68-year-old patient. Axial length: 23.6 mm: 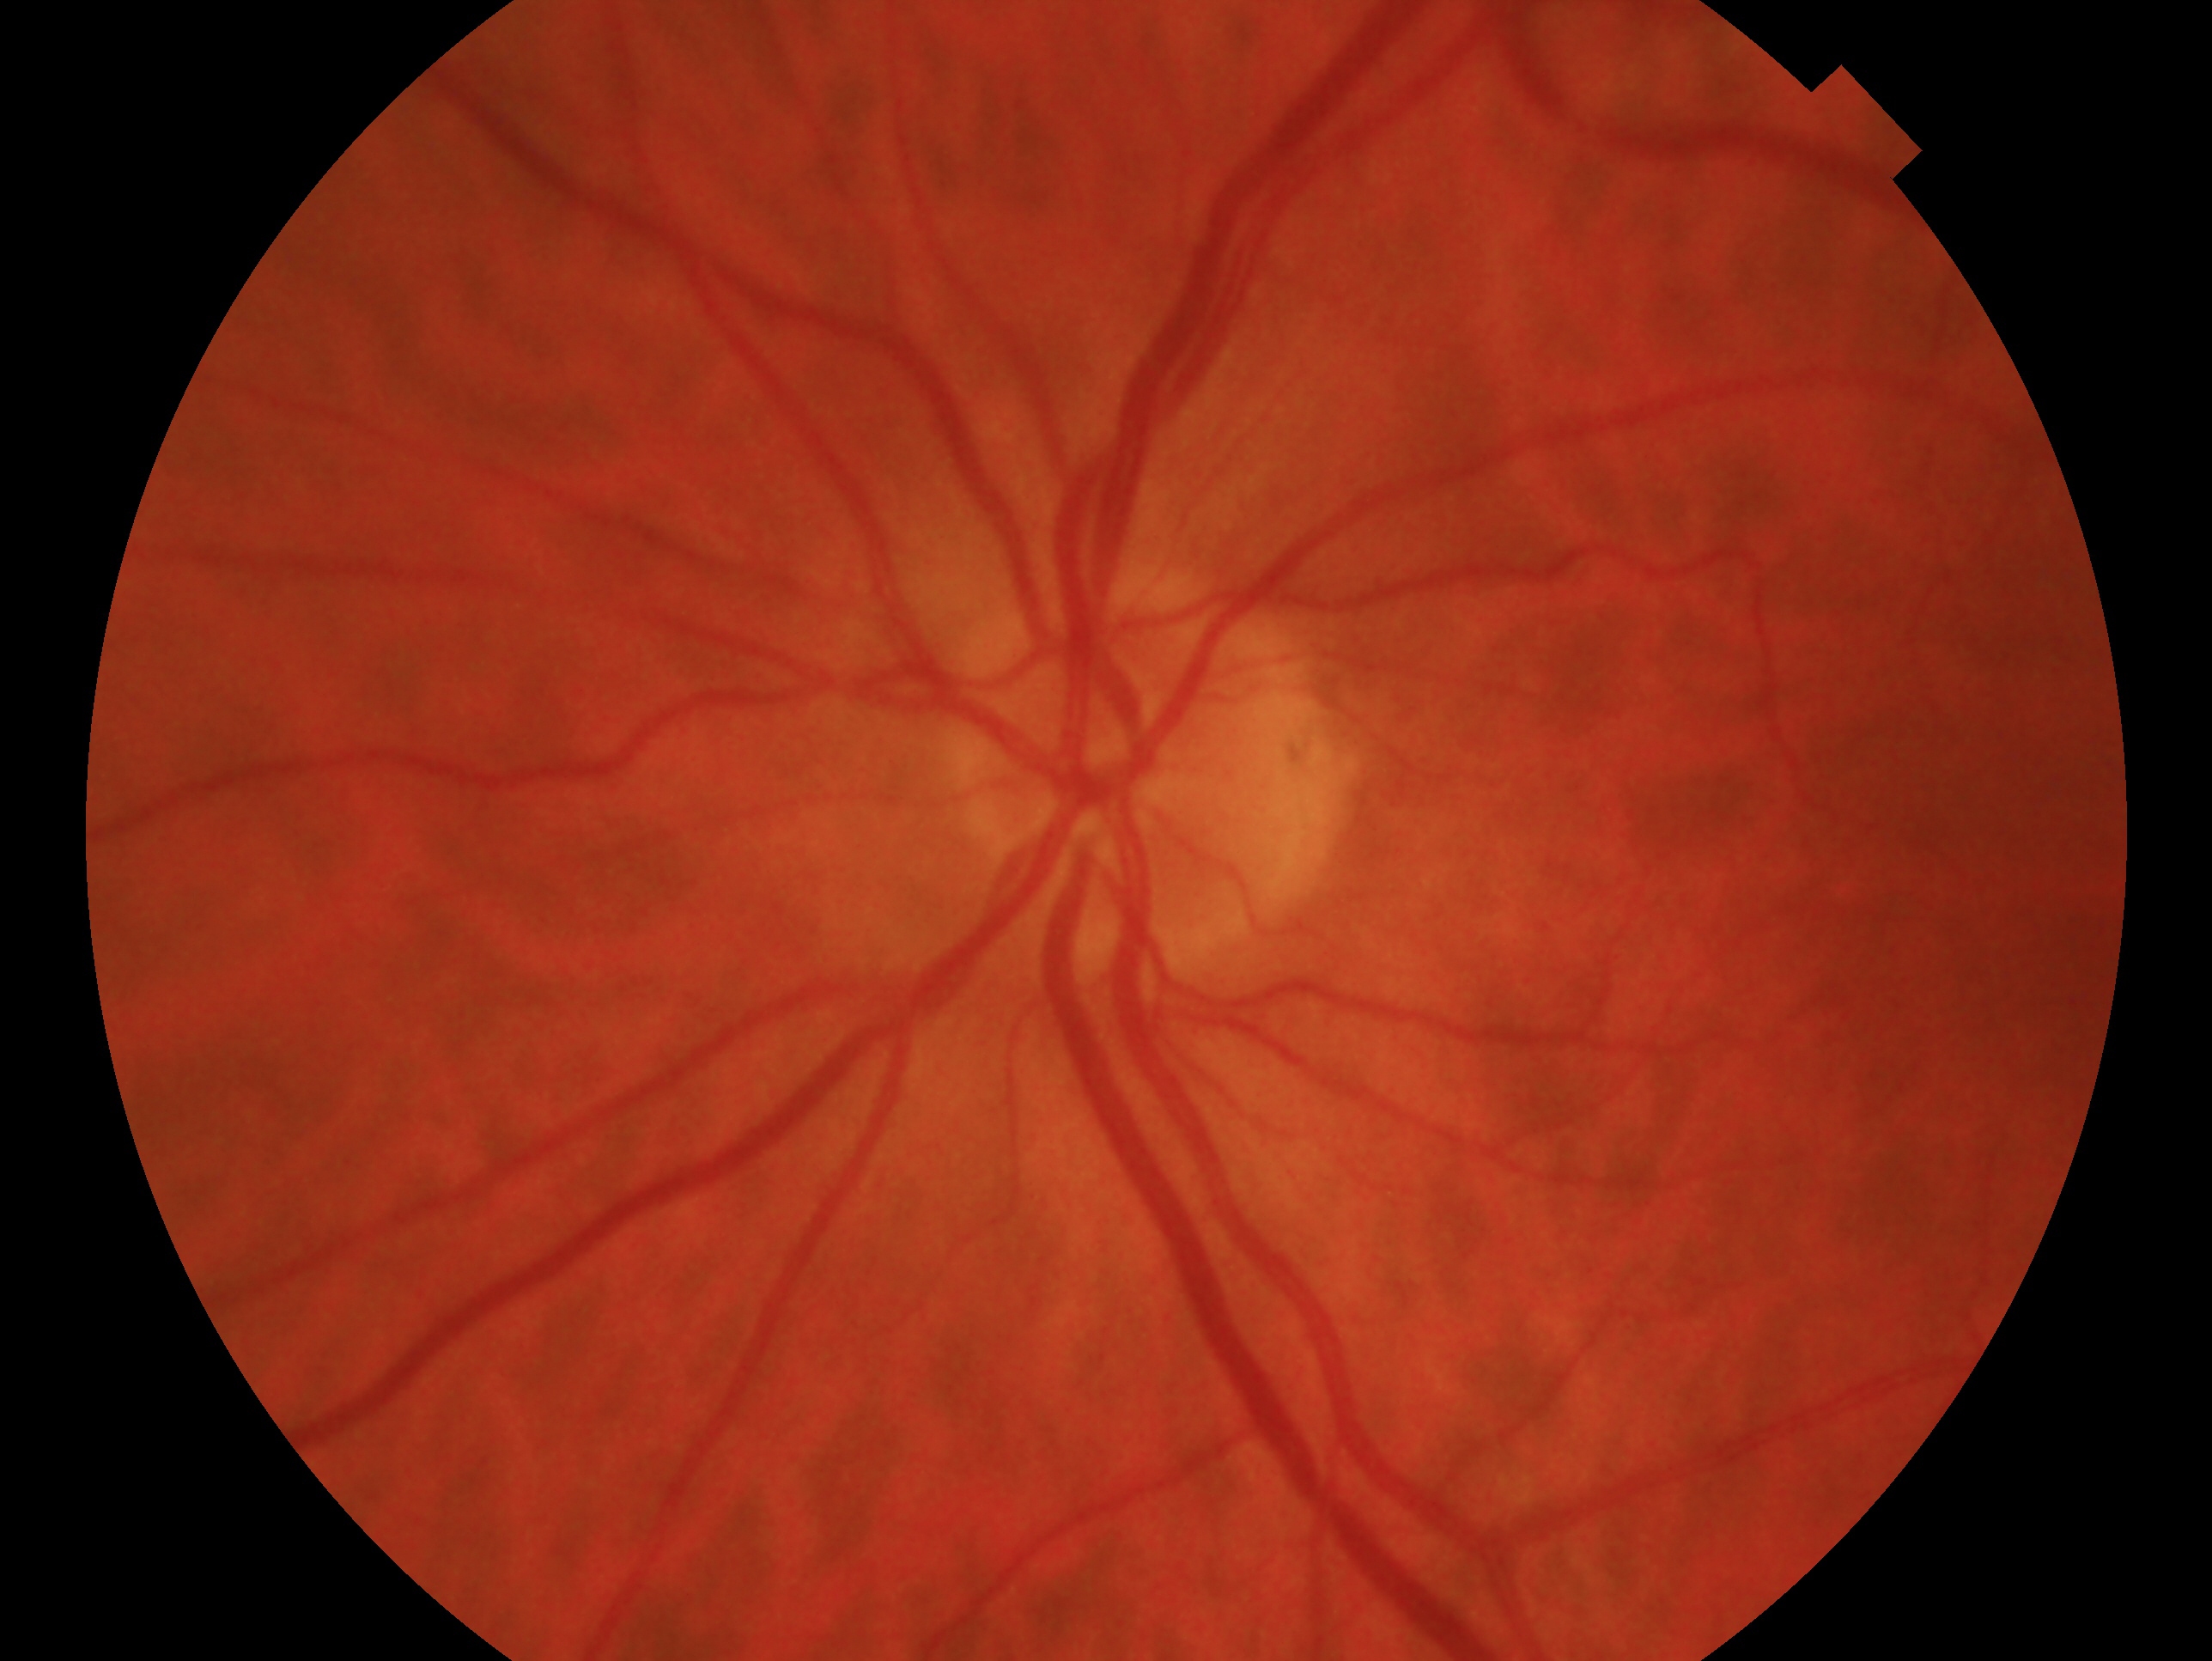

glaucoma_dx: no signs of glaucoma
eye: OS